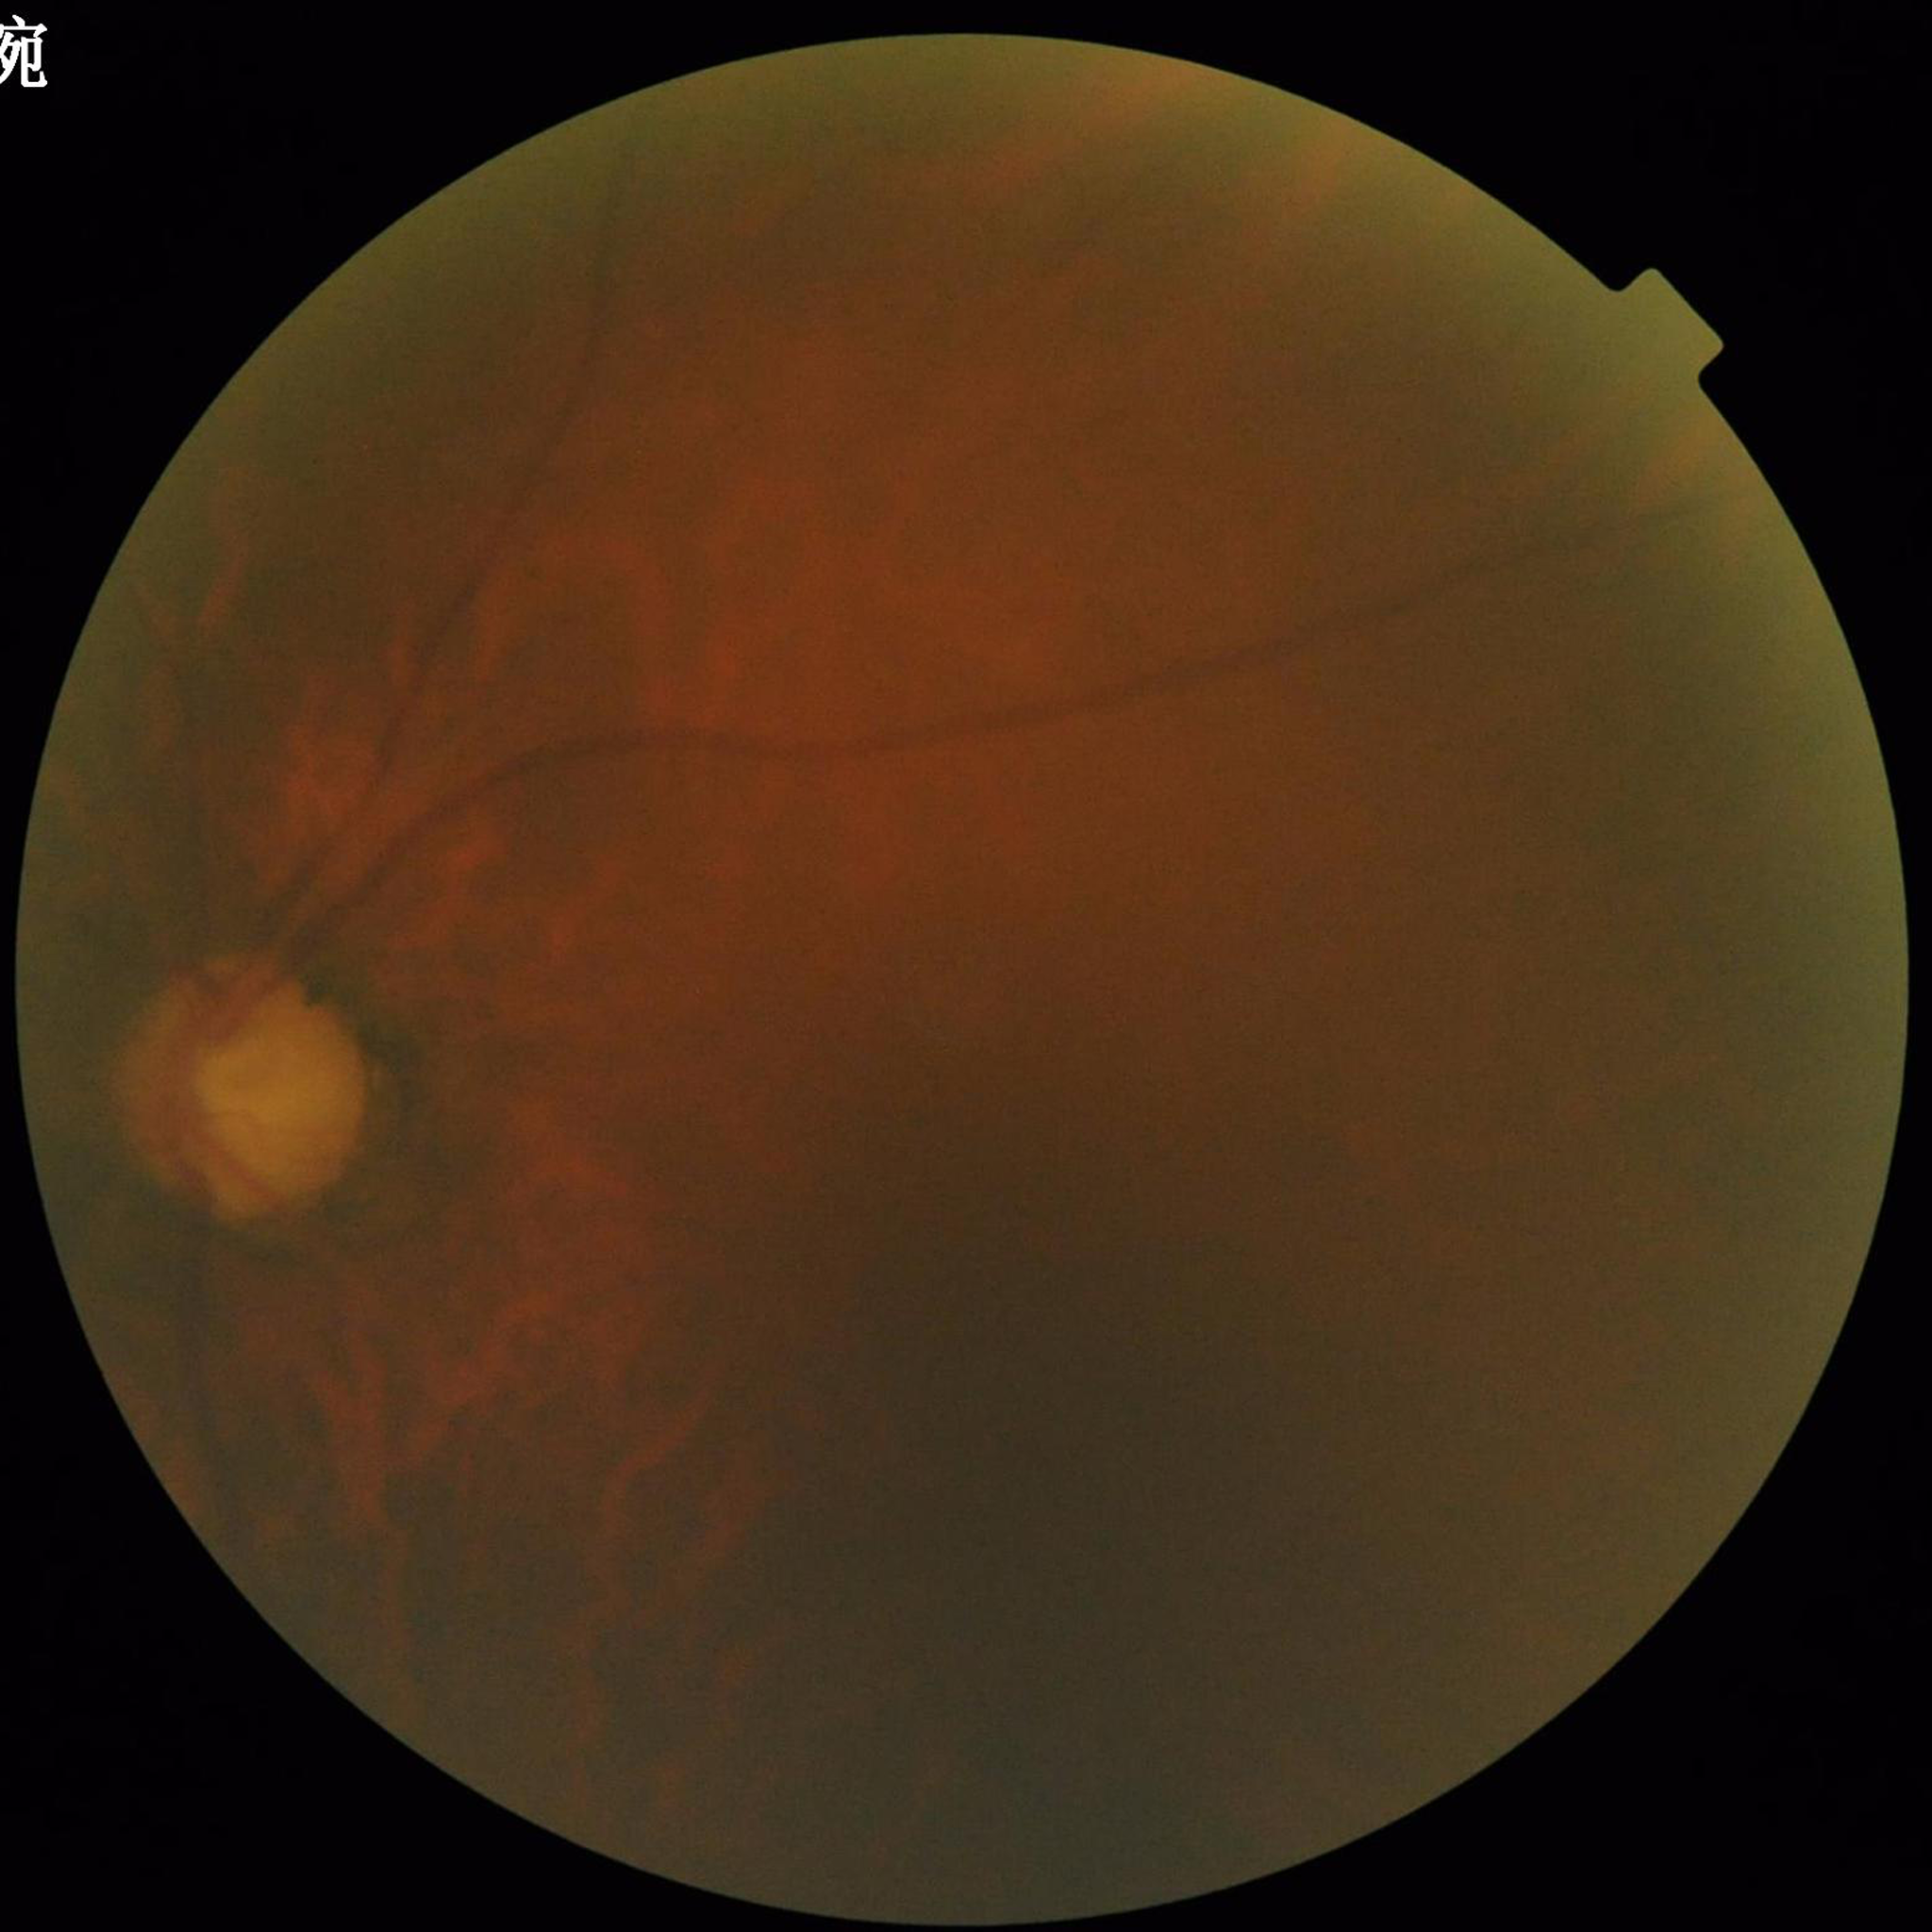
Image quality: issues noted — blur, illumination/color distortion, low contrast.
This fundus photograph is from a patient diagnosed with glaucoma.